Davis DR grading · 848 by 848 pixels.
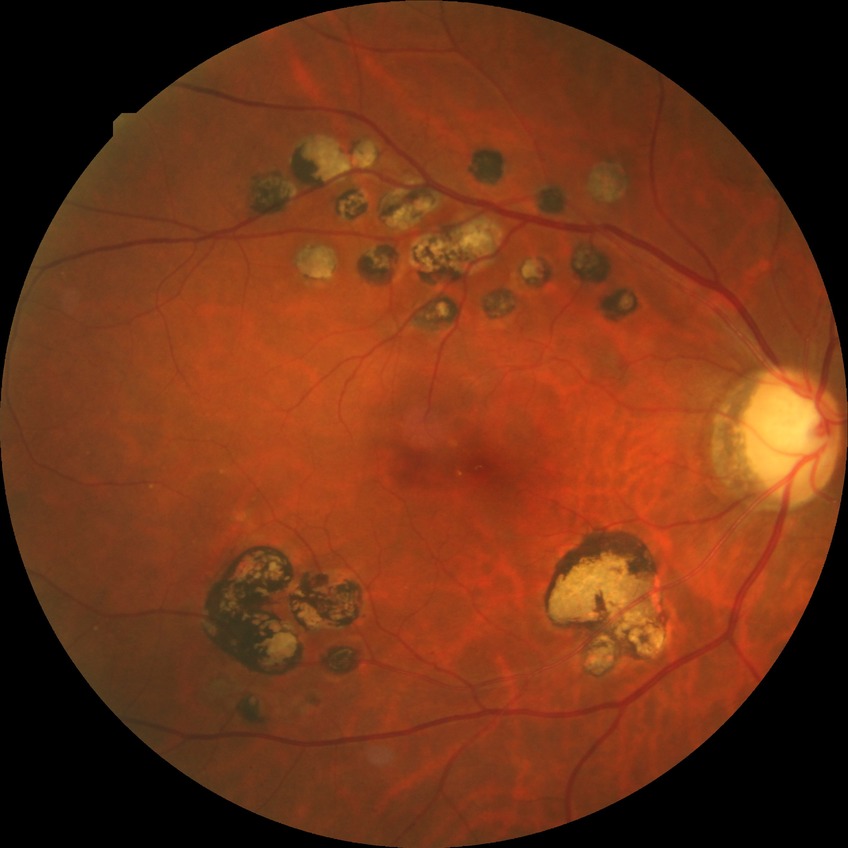

Diabetic retinopathy (DR): PDR (proliferative diabetic retinopathy).